Without pupil dilation · retinal fundus photograph · 45° FOV · NIDEK AFC-230
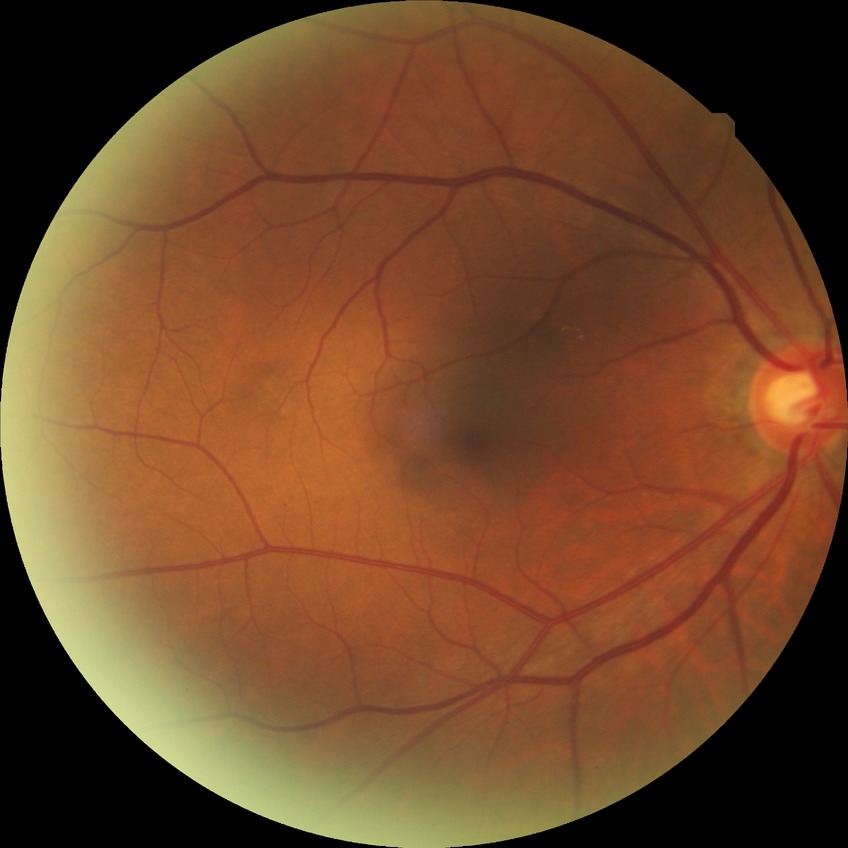
davis_grade: no diabetic retinopathy